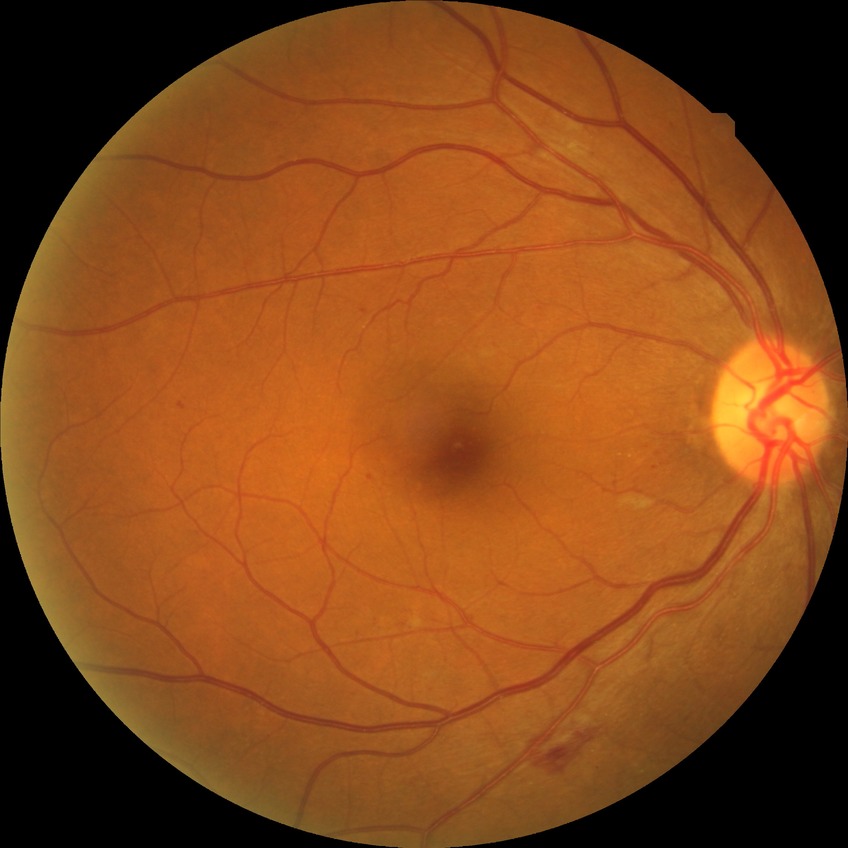
{
  "davis_grade": "simple diabetic retinopathy"
}